2048 x 1536 pixels — 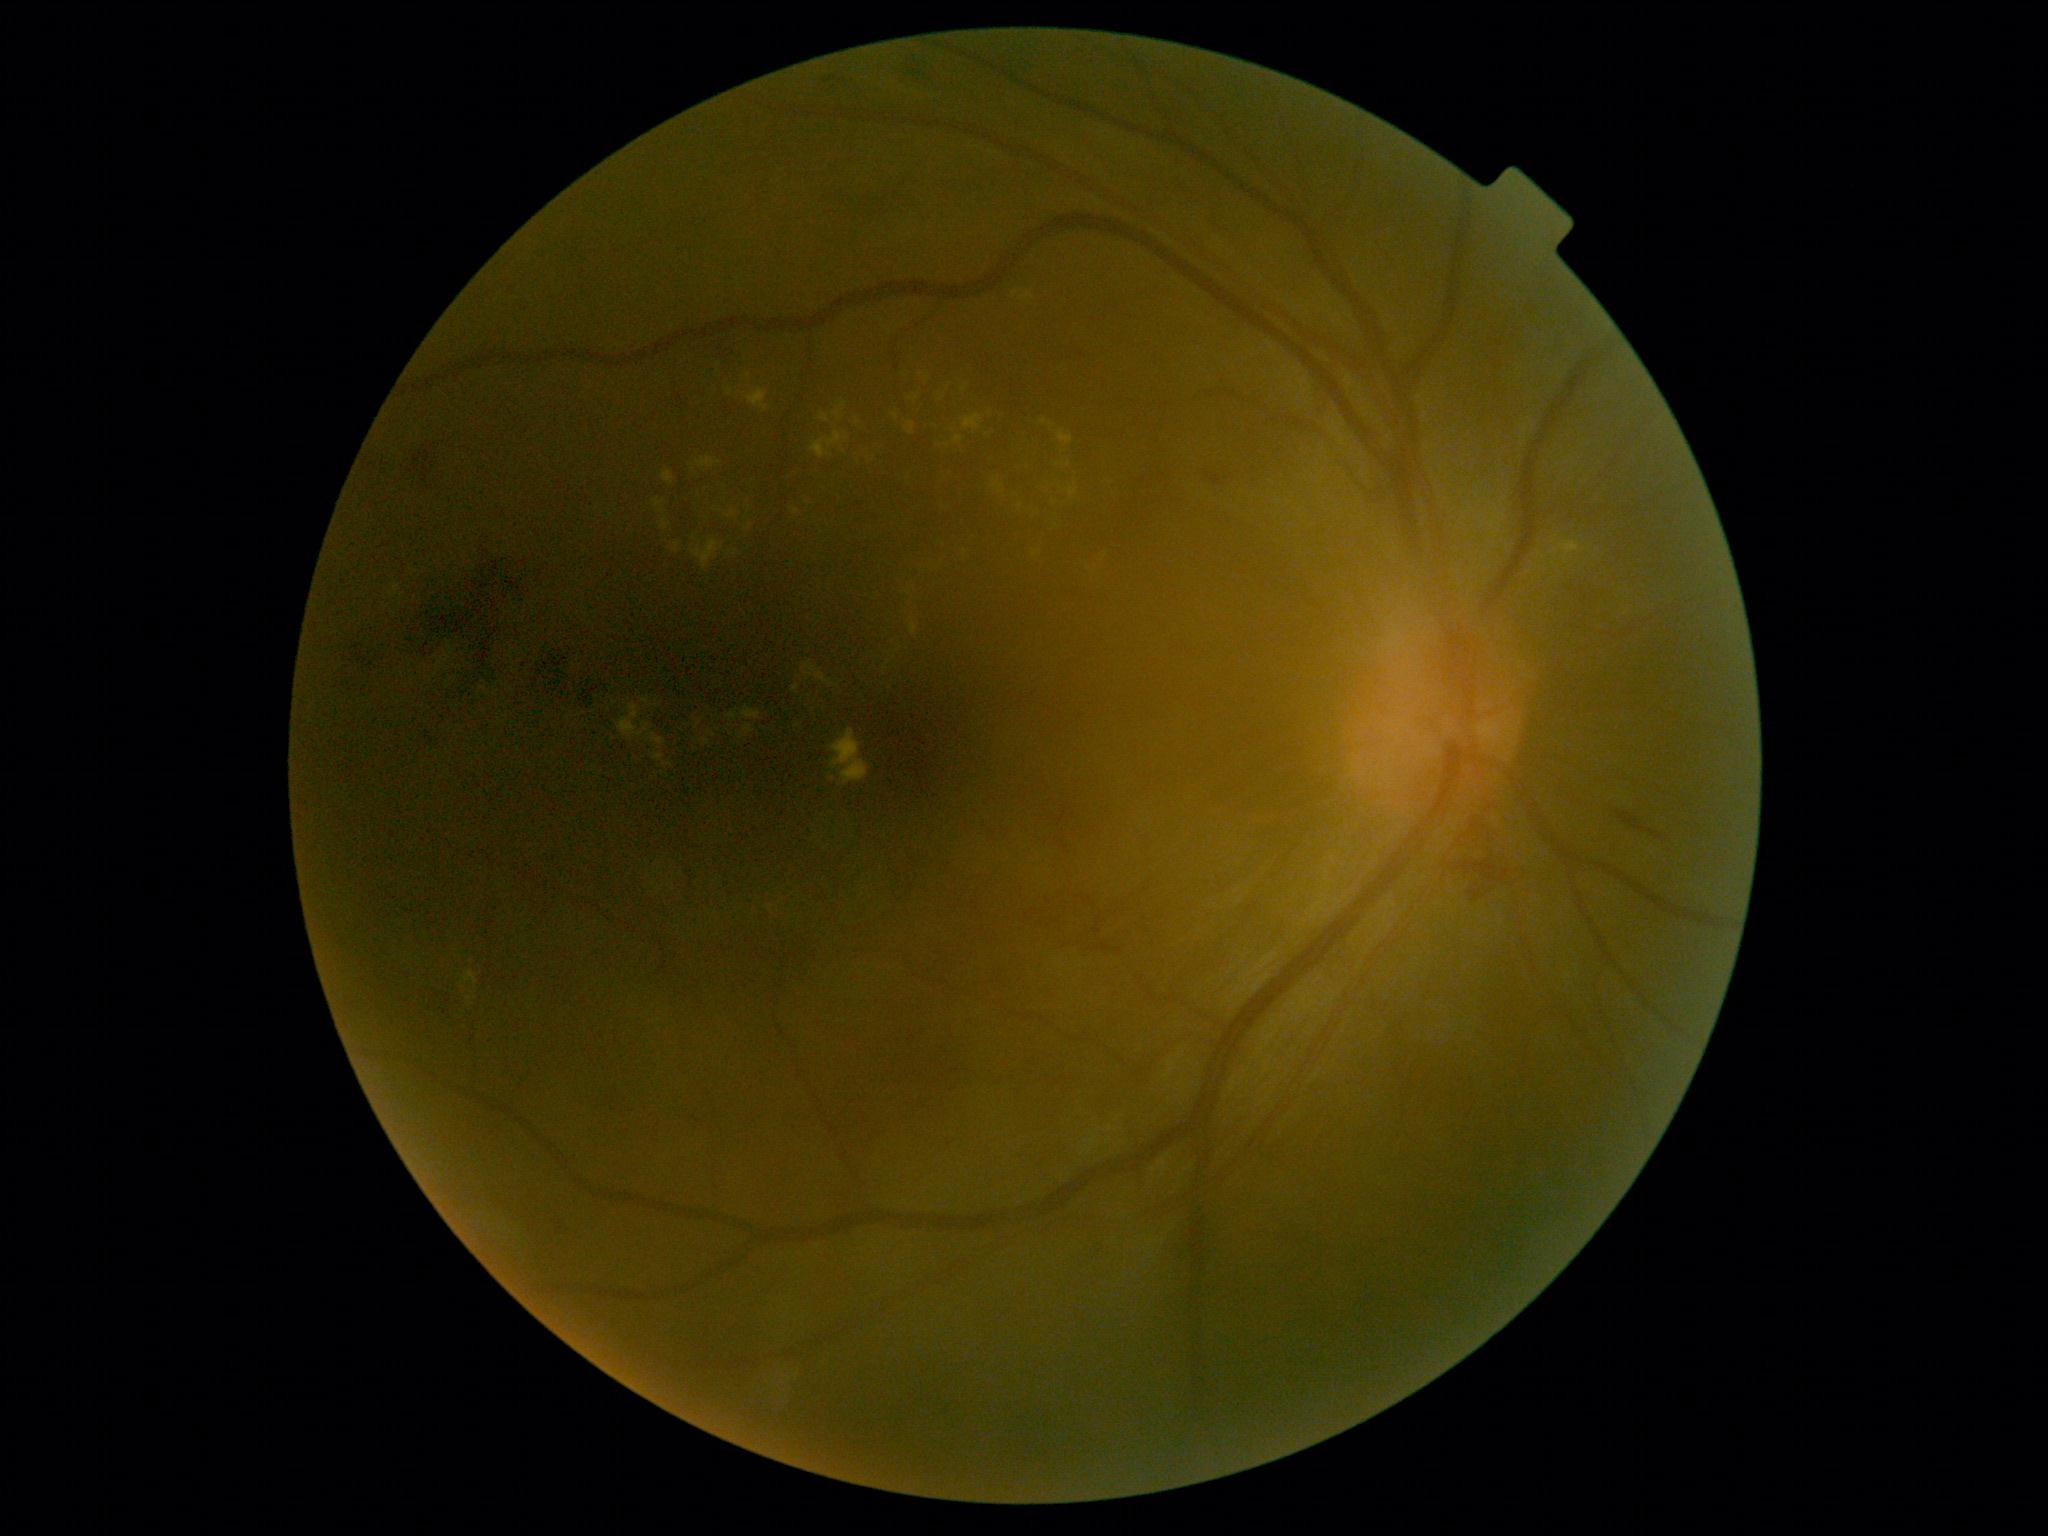

Diabetic retinopathy grade is 2 (moderate NPDR).